Modified Davis grading.
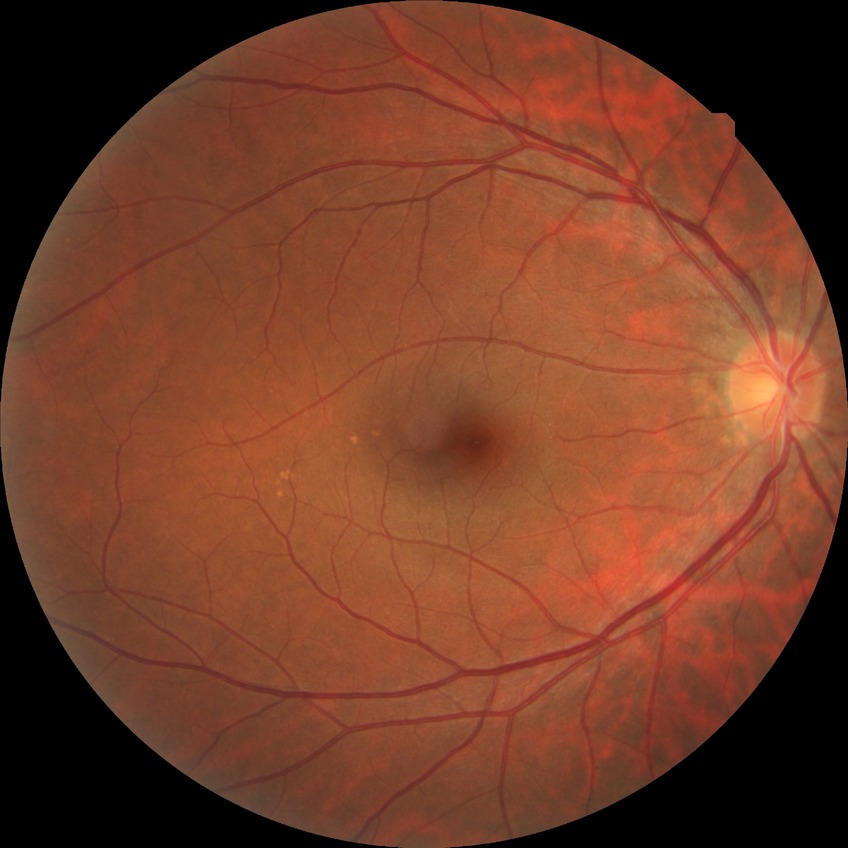

Modified Davis classification is no diabetic retinopathy.